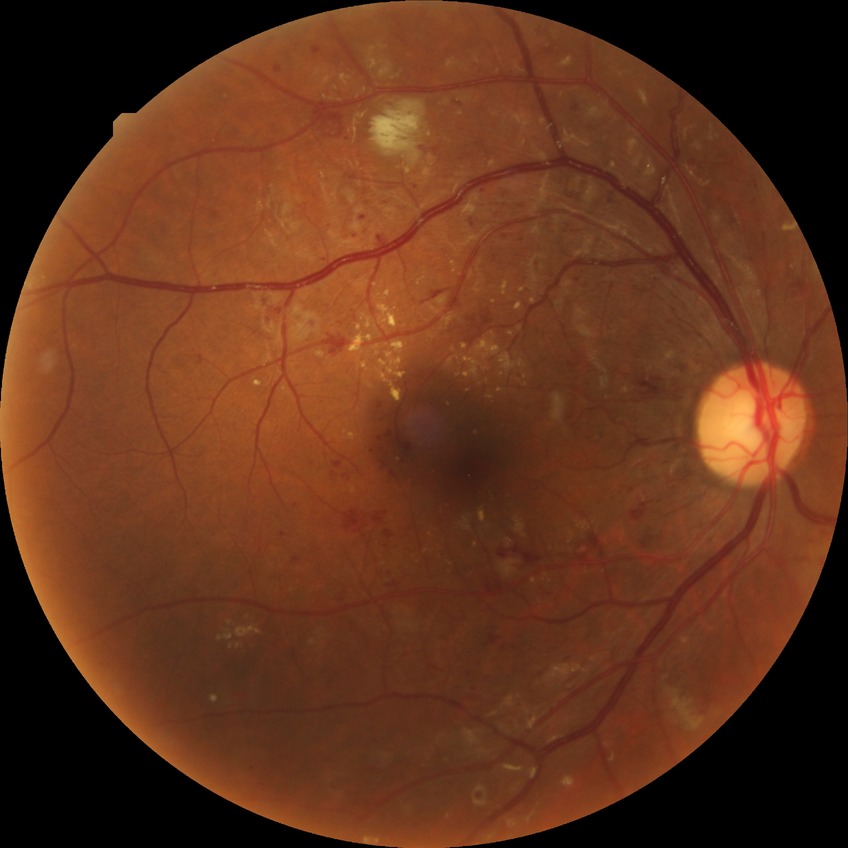

Davis stage: PPDR.